Camera: Nidek AFC-330; optic nerve head crop; retinal fundus photograph — 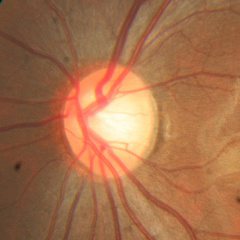
Glaucoma assessment = no glaucomatous optic neuropathy.